640x480px; wide-field fundus photograph of an infant:
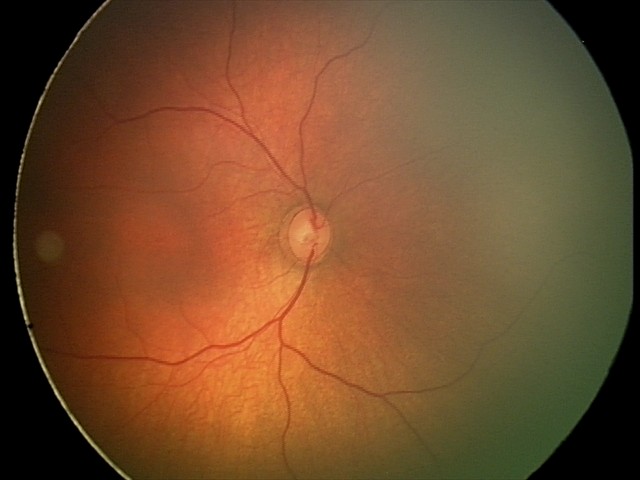

Finding: physiological appearance.